CFP · camera: NIDEK AFC-230 · without pupil dilation · 848 x 848 pixels
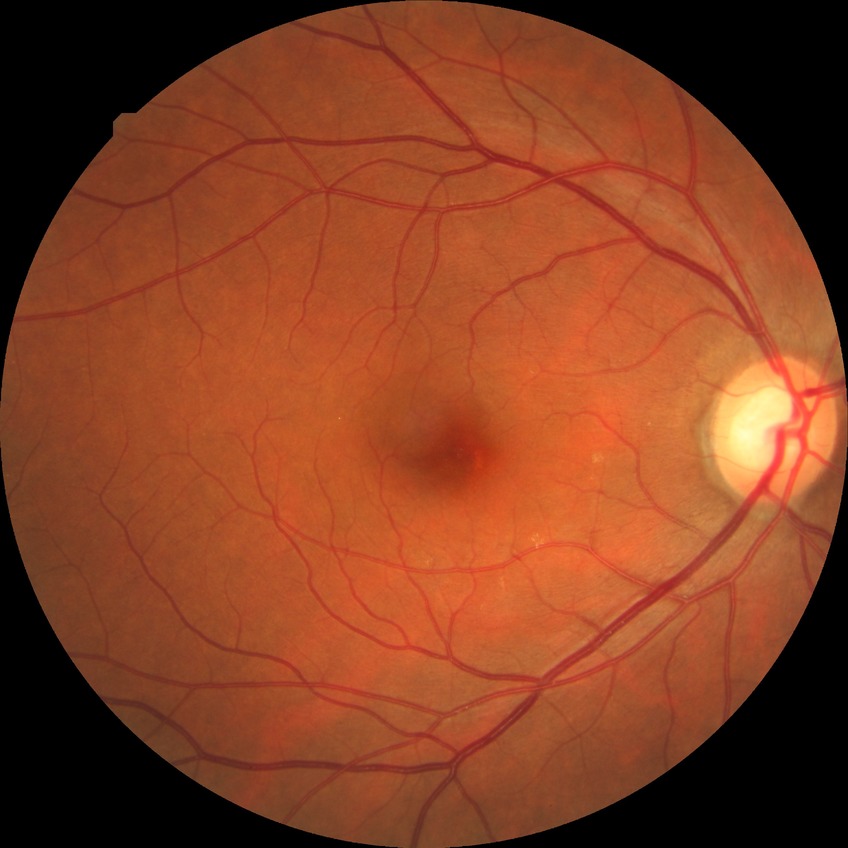
Modified Davis classification: simple diabetic retinopathy.